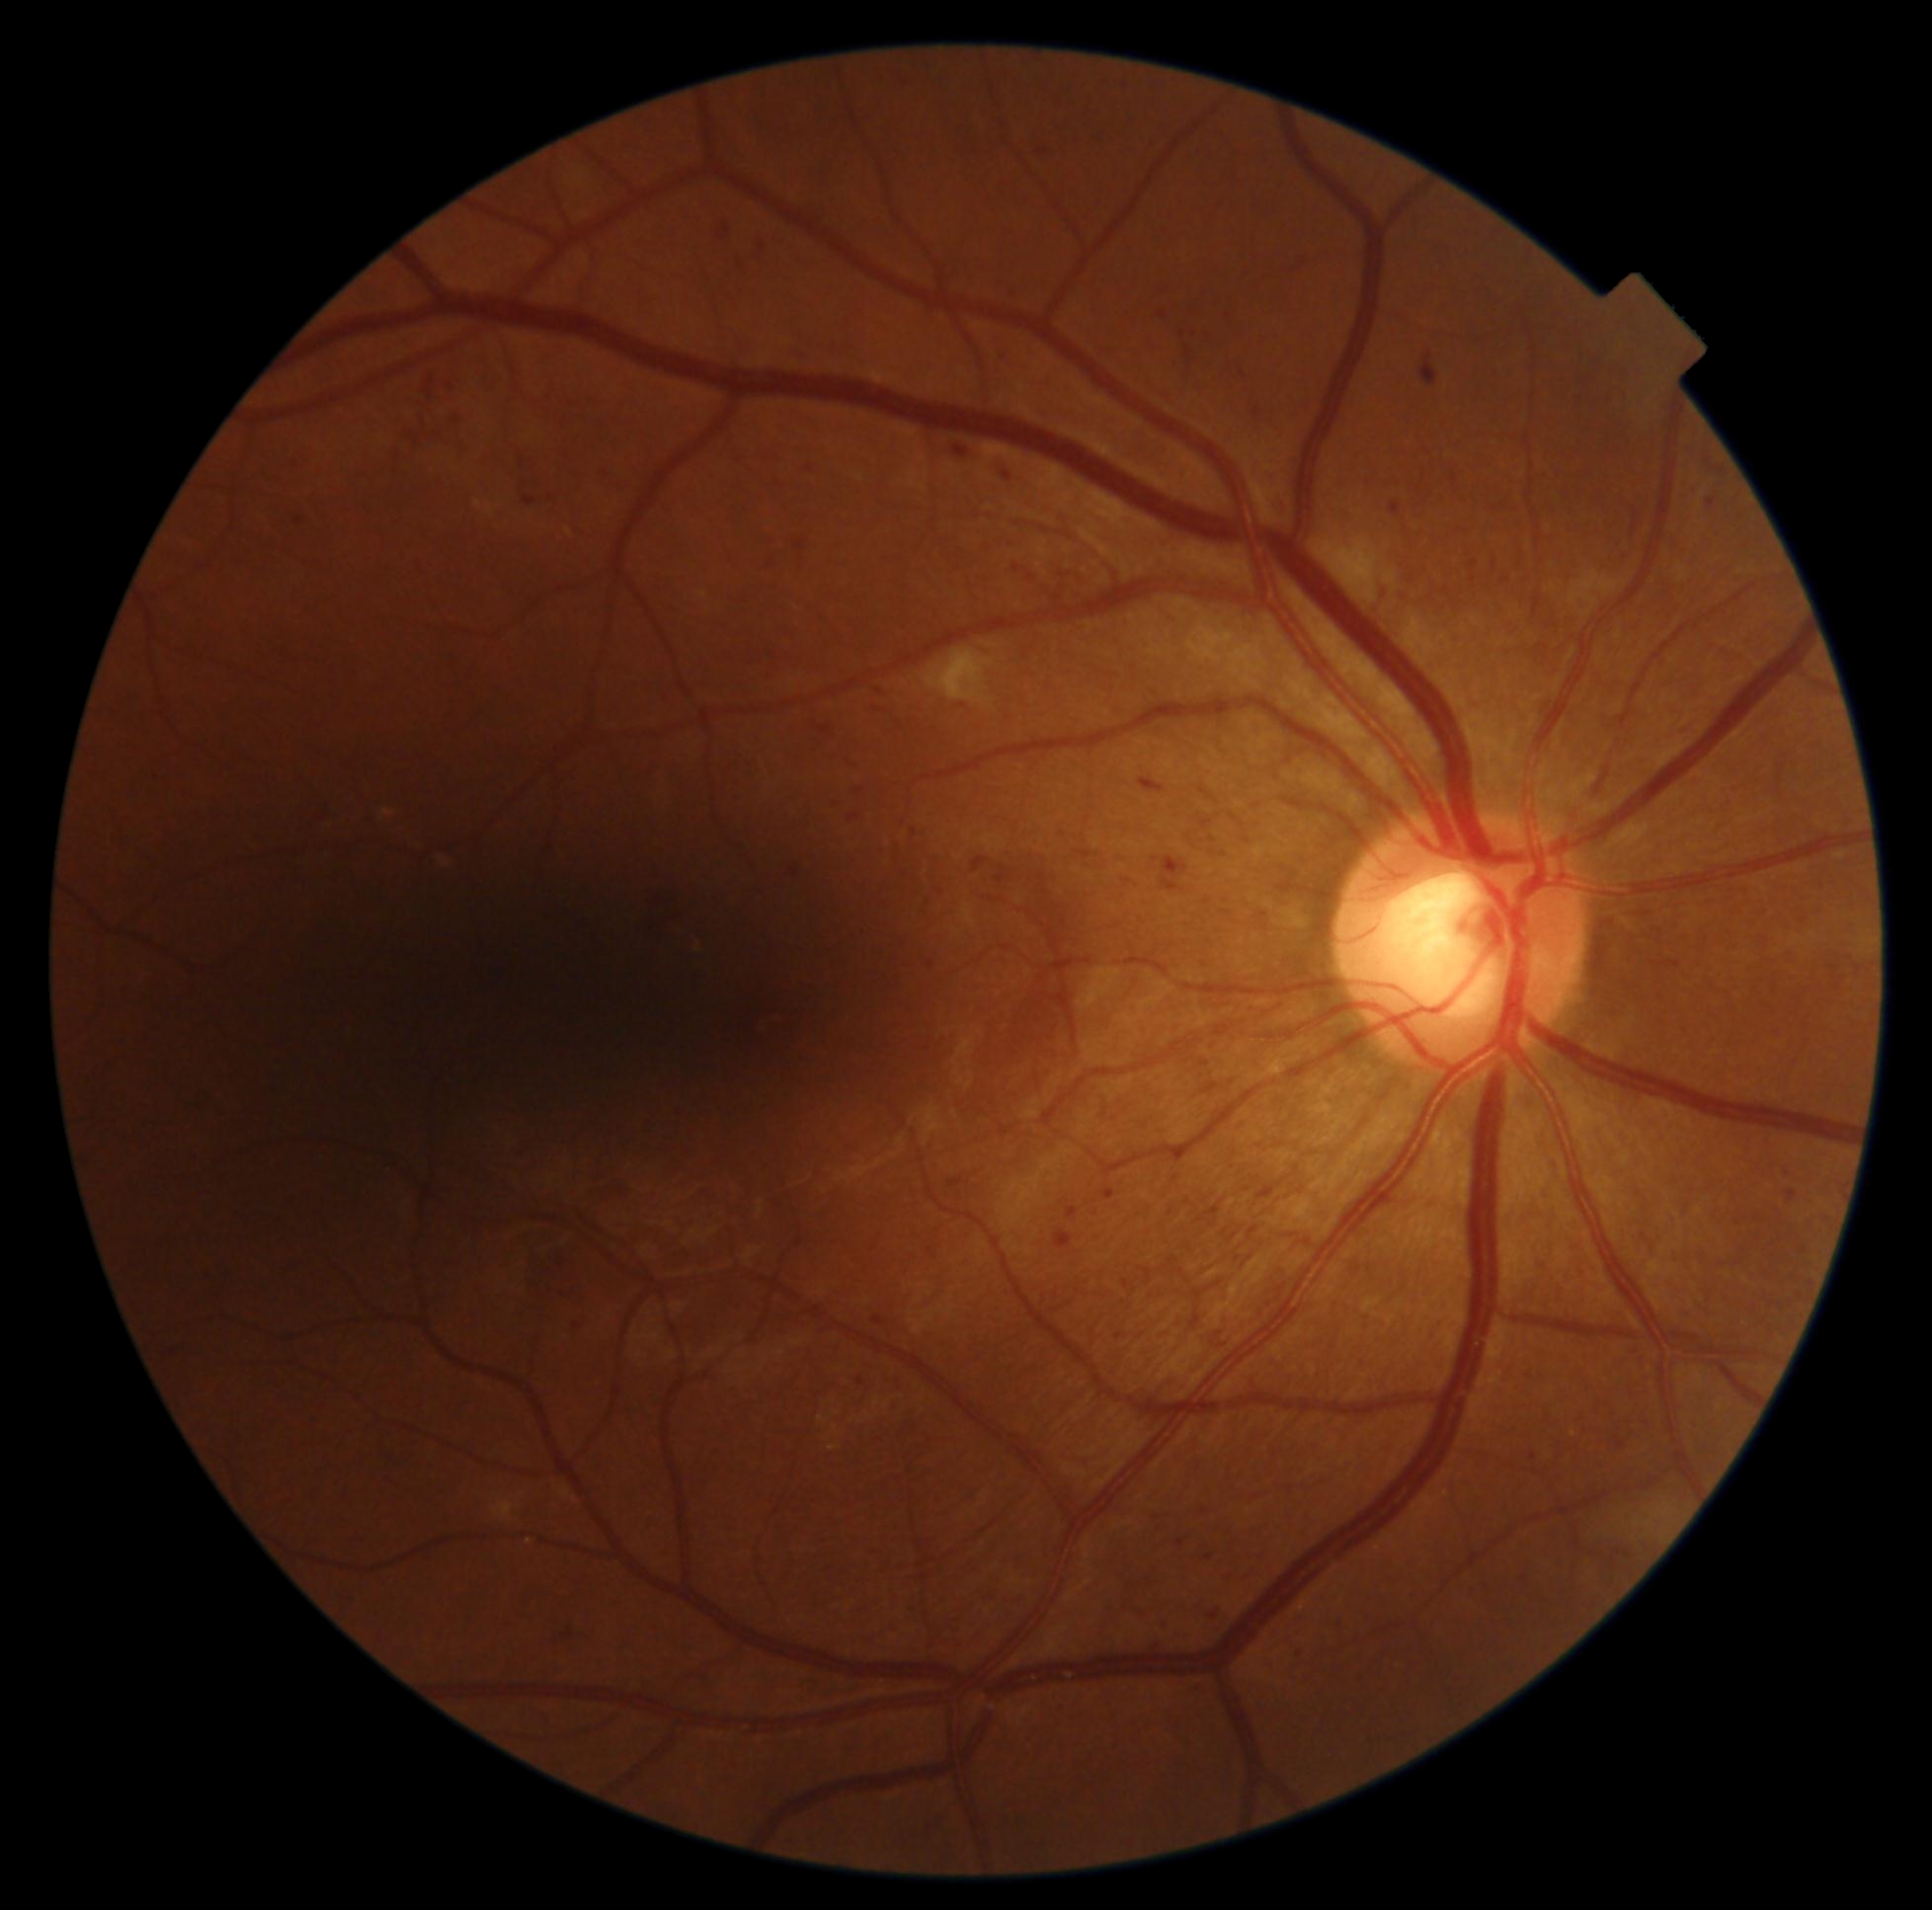
DR severity: grade 2 (moderate NPDR)
Representative lesions:
EXs: none detected
HEs: none detected
SEs: rect(926, 649, 996, 708) | rect(1324, 538, 1380, 587)
MAs (continued): rect(1055, 1230, 1073, 1250) | rect(1204, 1553, 1215, 1560) | rect(426, 376, 435, 398) | rect(1101, 1188, 1116, 1201) | rect(1295, 1648, 1306, 1659) | rect(1717, 466, 1726, 473) | rect(1161, 856, 1189, 893) | rect(876, 710, 888, 713) | rect(795, 539, 808, 552) | rect(856, 788, 863, 796) | rect(872, 1316, 887, 1326) | rect(996, 865, 1008, 884) | rect(848, 814, 859, 823)
Additional small MAs near [1215, 1616] | [1047, 1075] | [880, 692] | [1033, 577]